45° FOV, retinal fundus photograph, 2352x1568px:
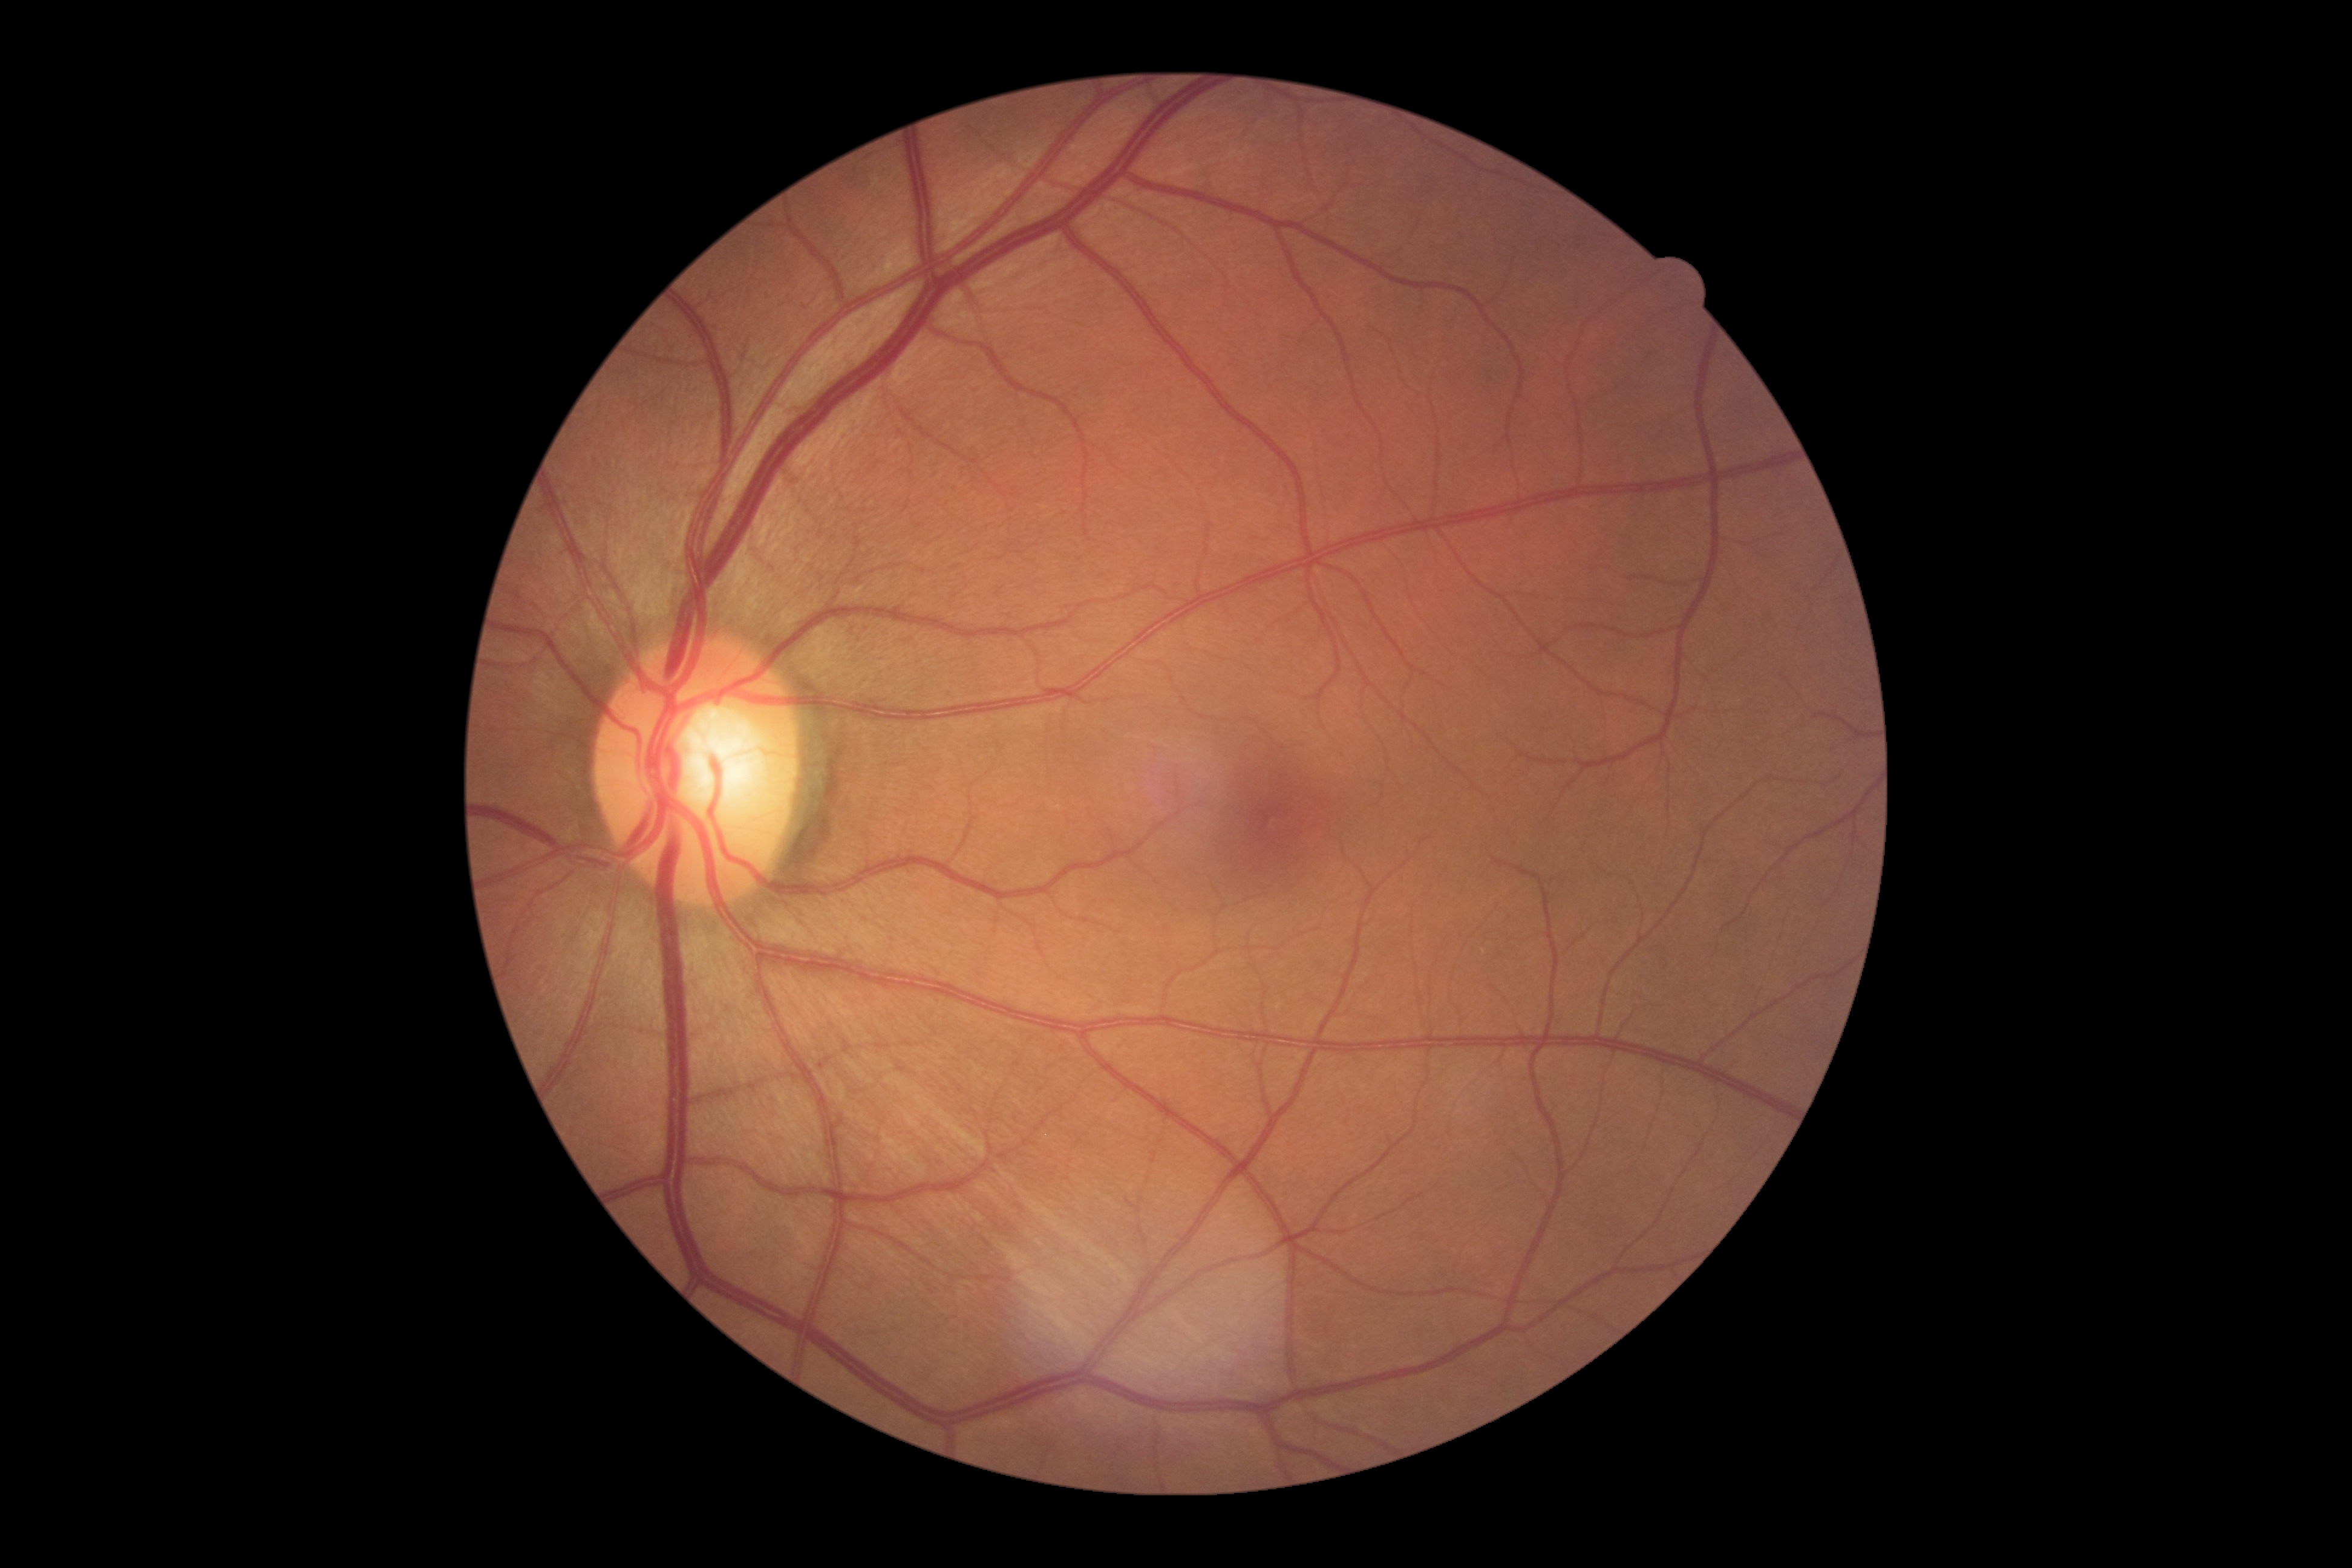 diabetic retinopathy (DR): no apparent diabetic retinopathy (grade 0) — no visible signs of diabetic retinopathy.